45-degree field of view: 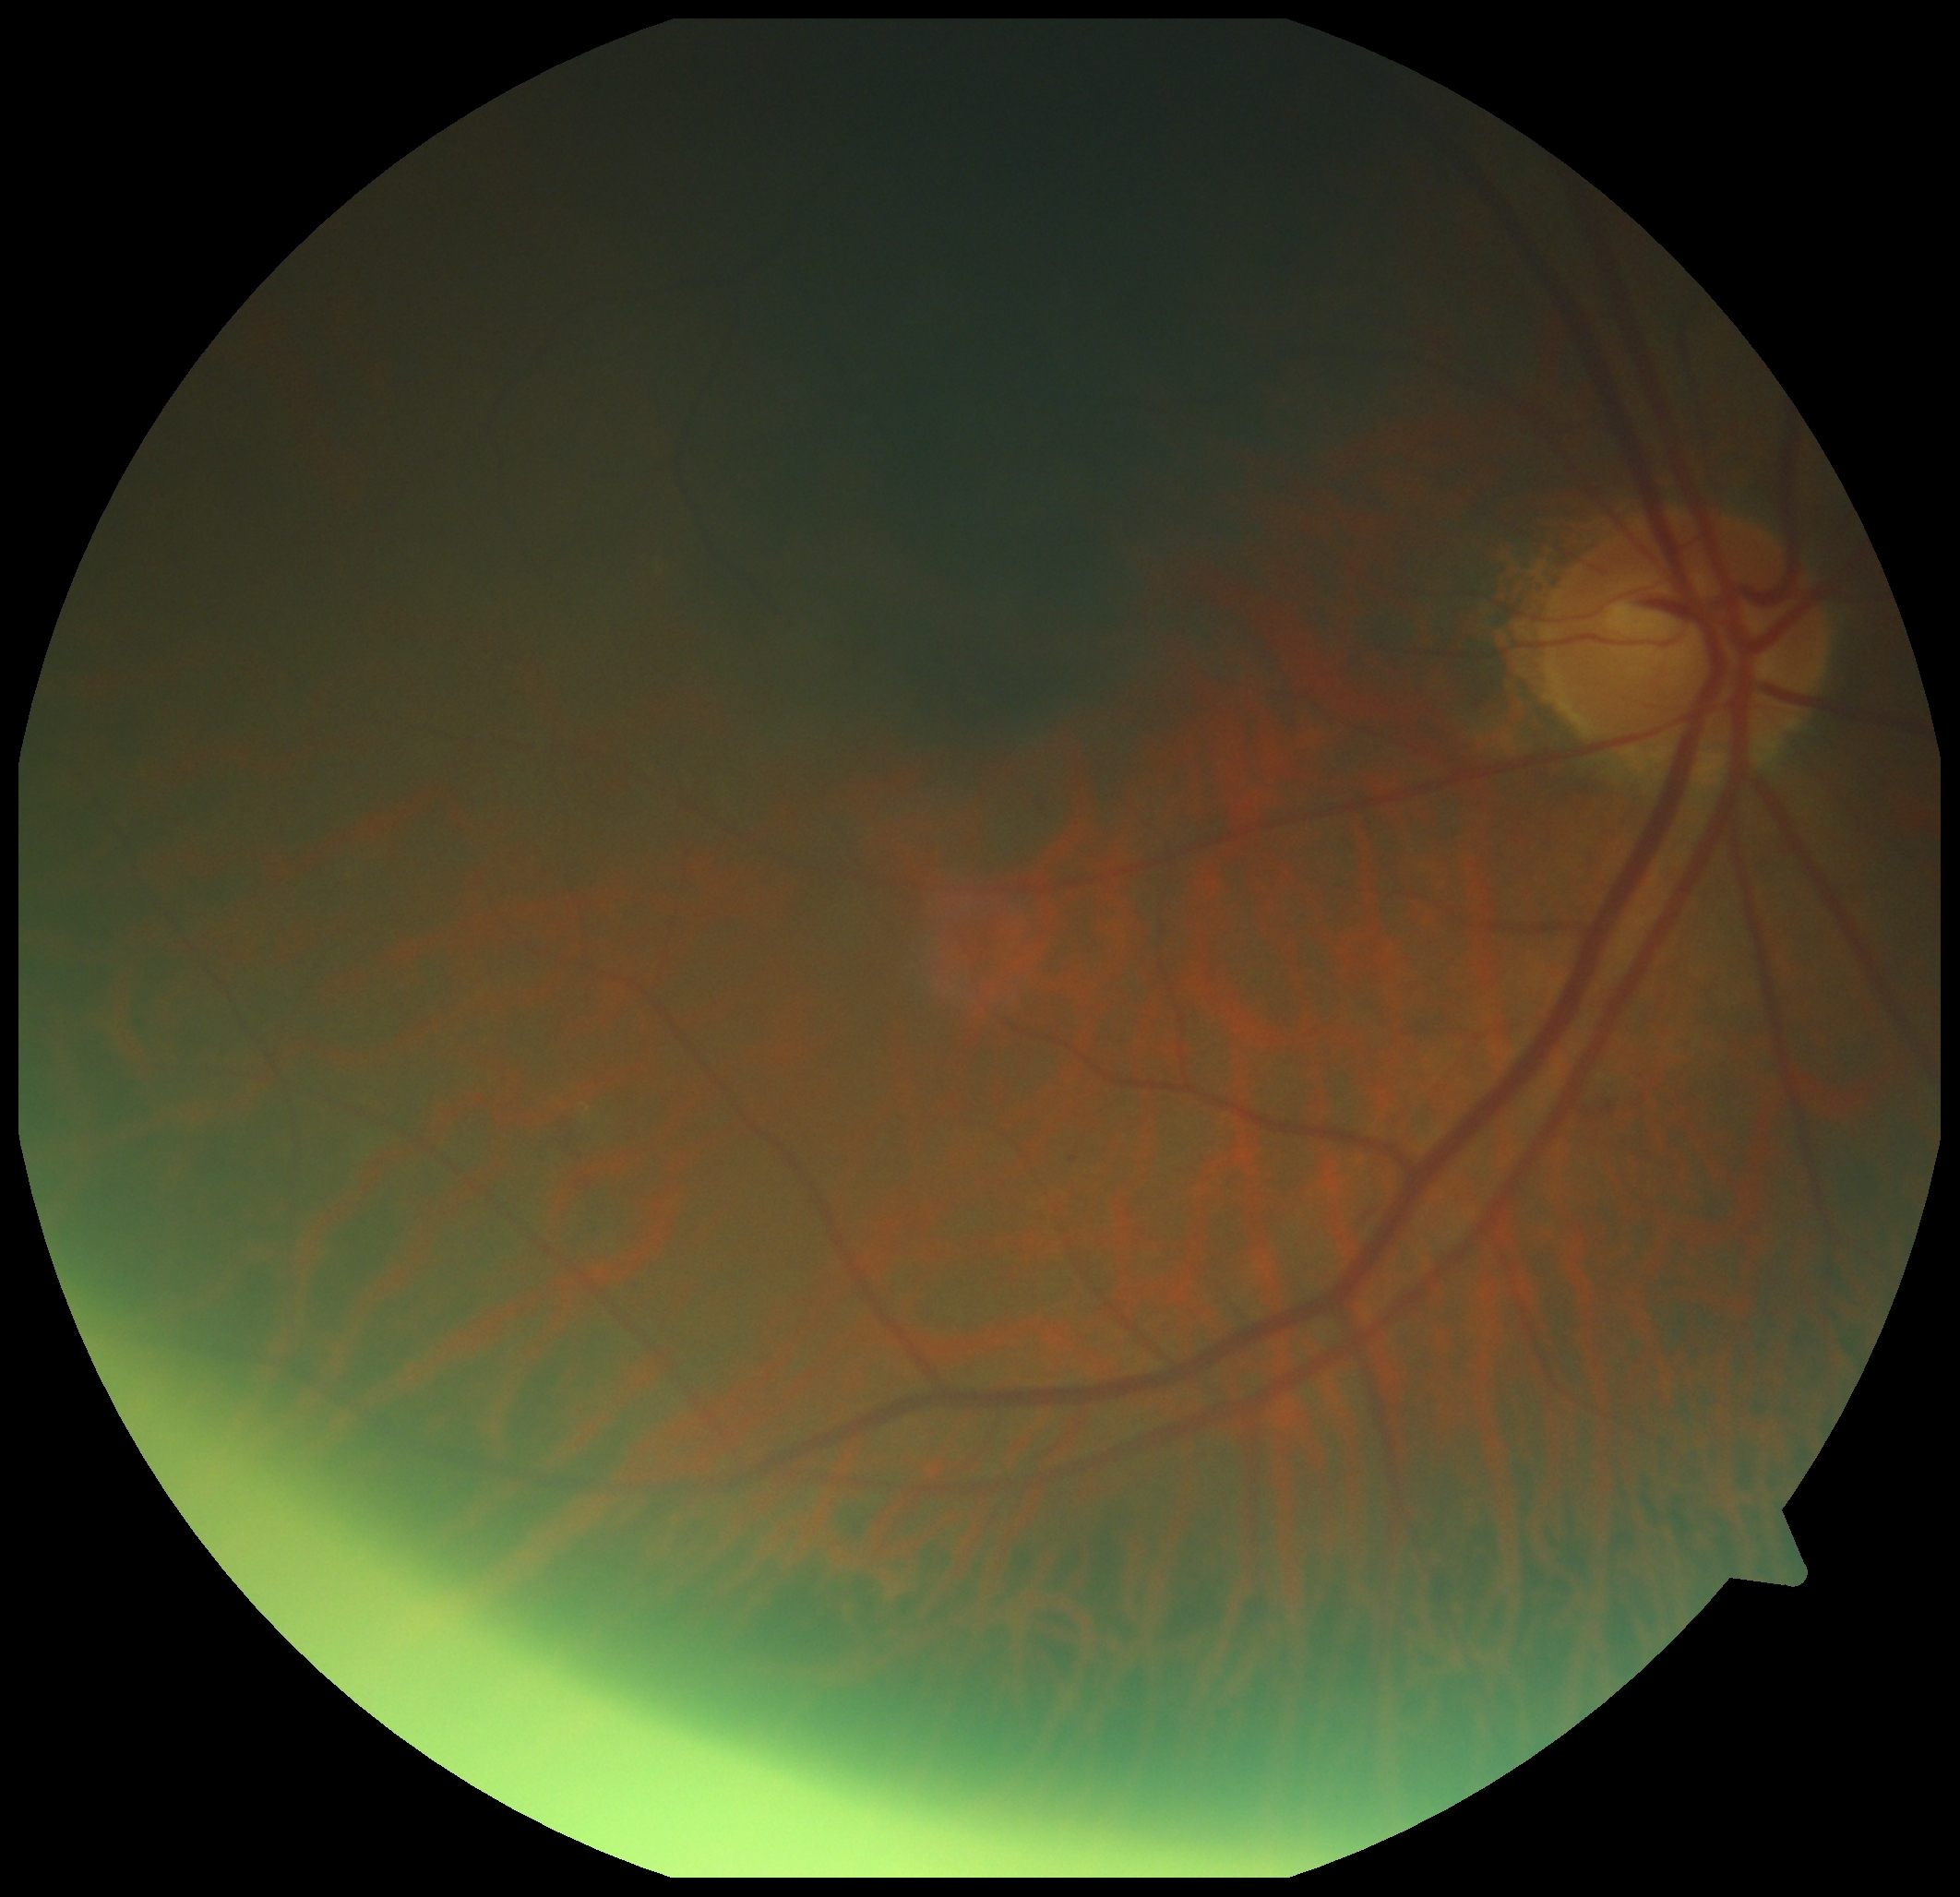 dr_grade: 2/4